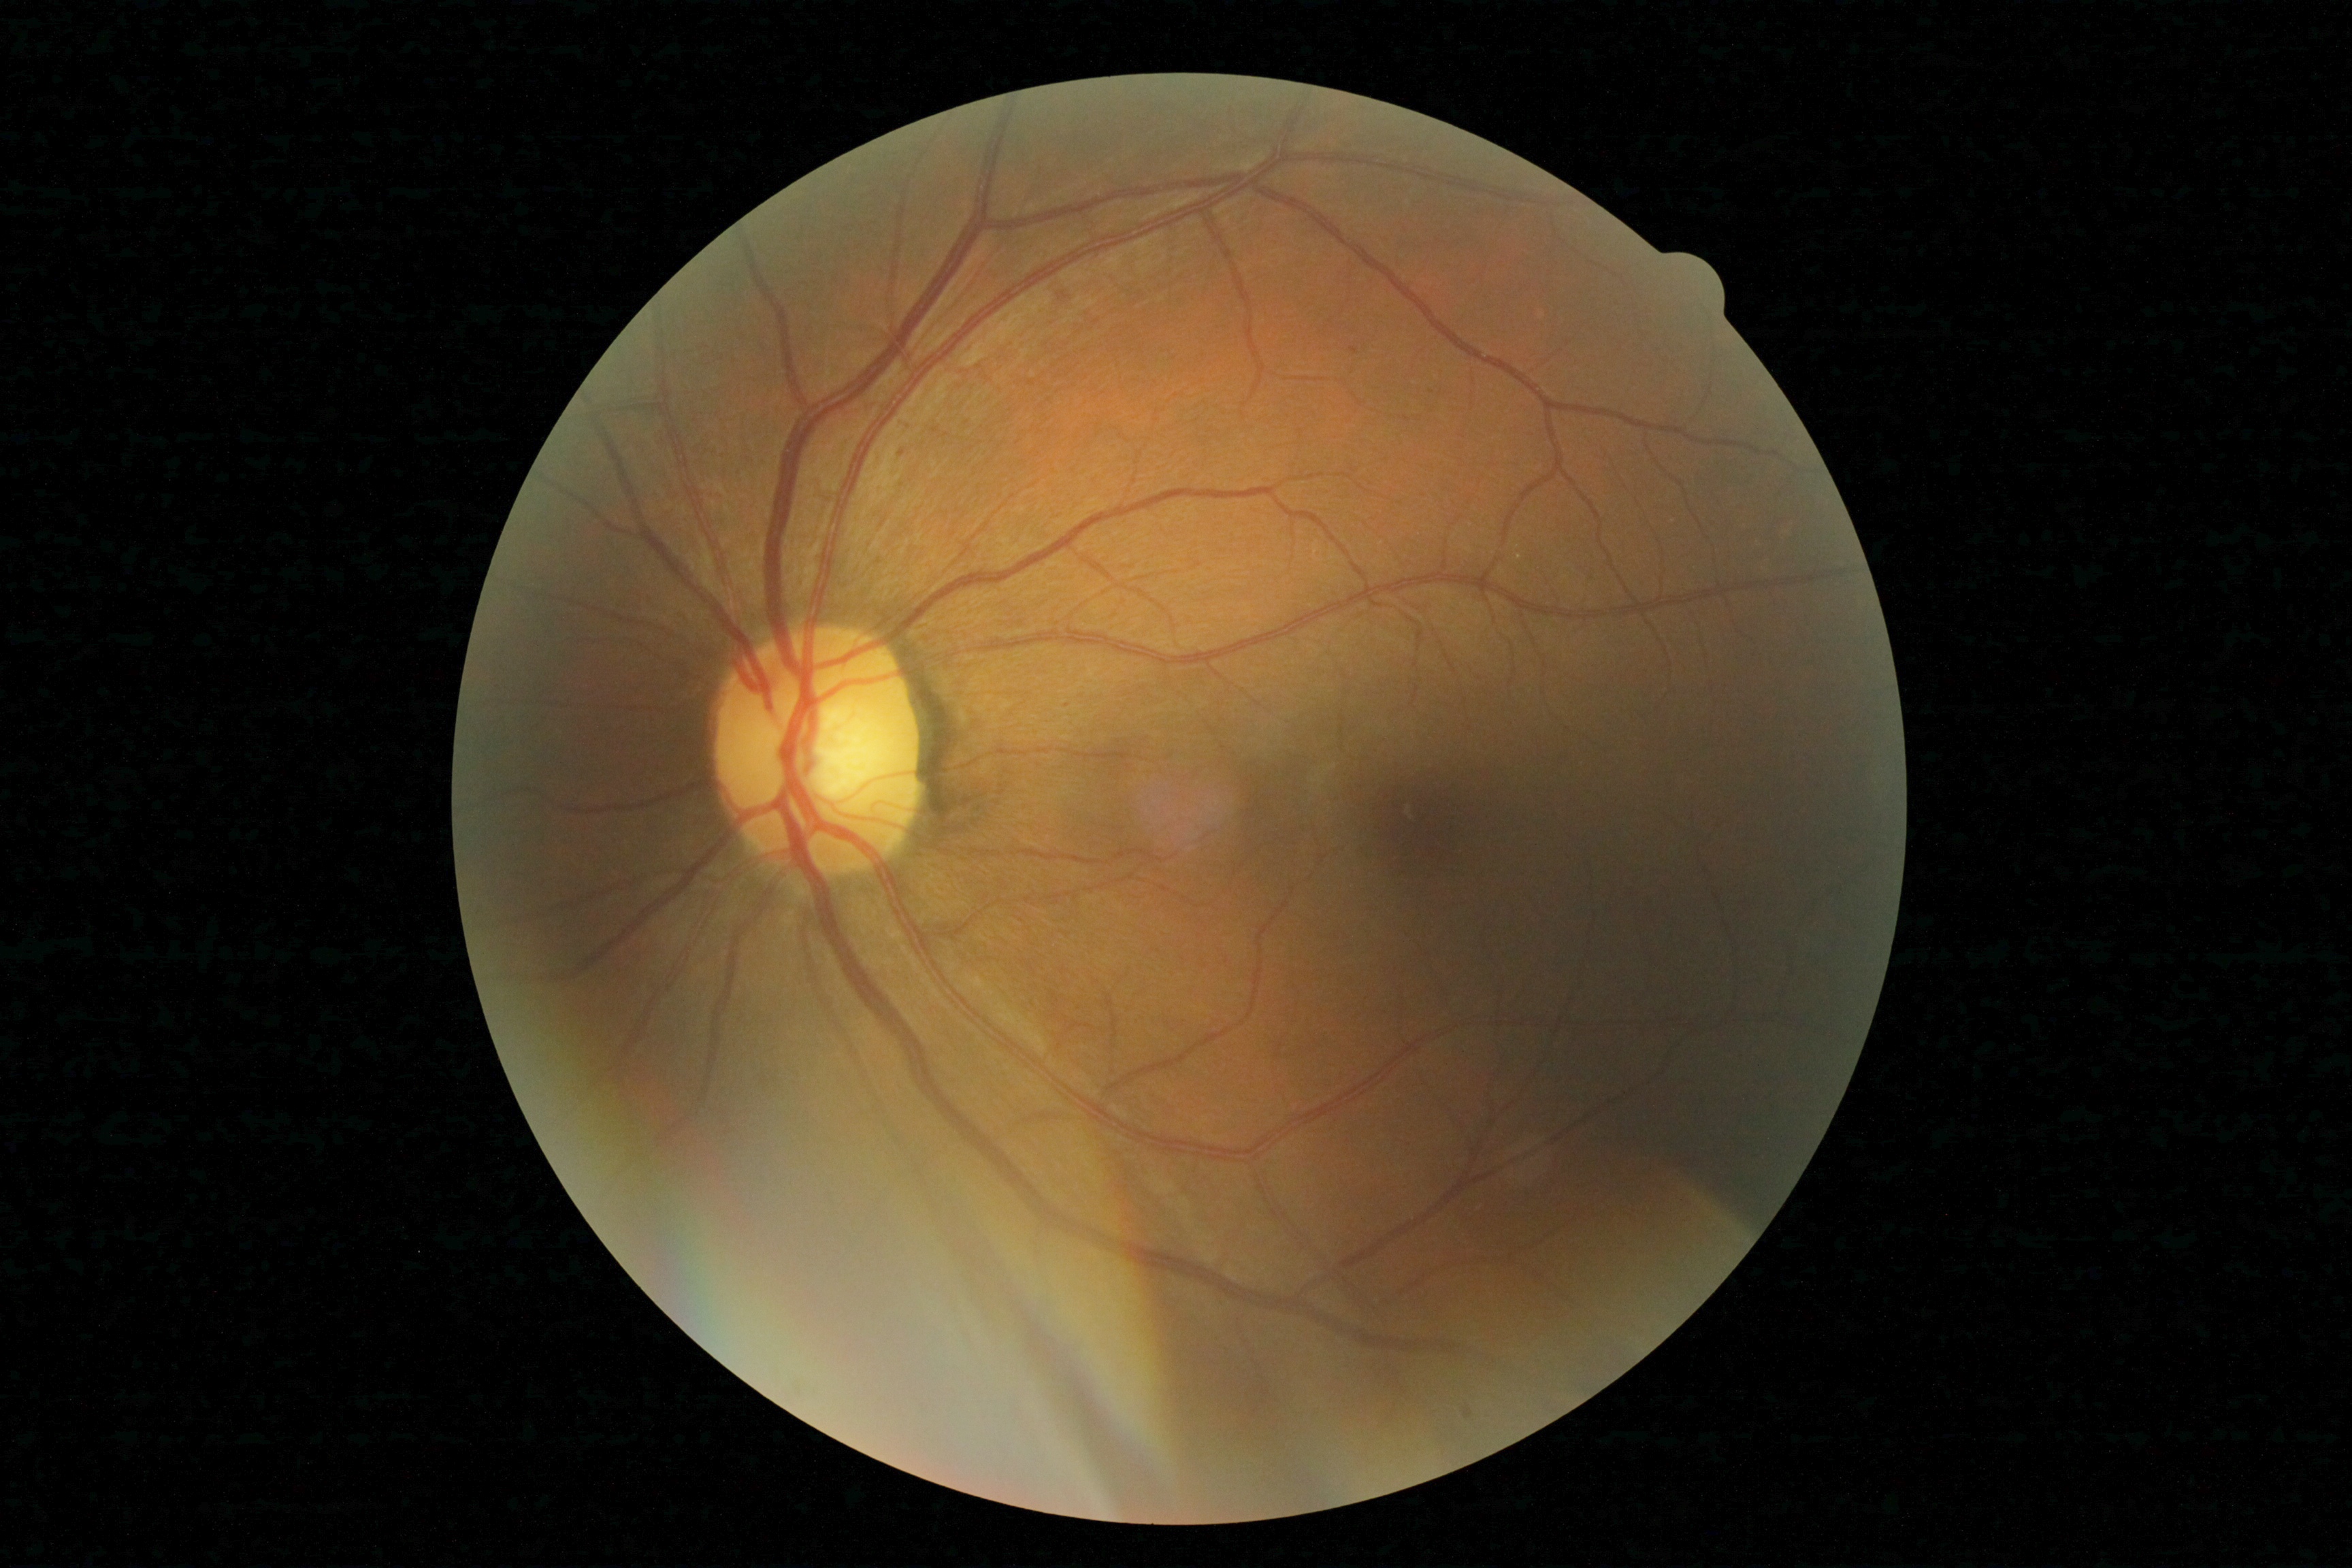
Disease class: non-proliferative diabetic retinopathy. DR stage is 1.